Acquired with a Topcon TRC-NW400: 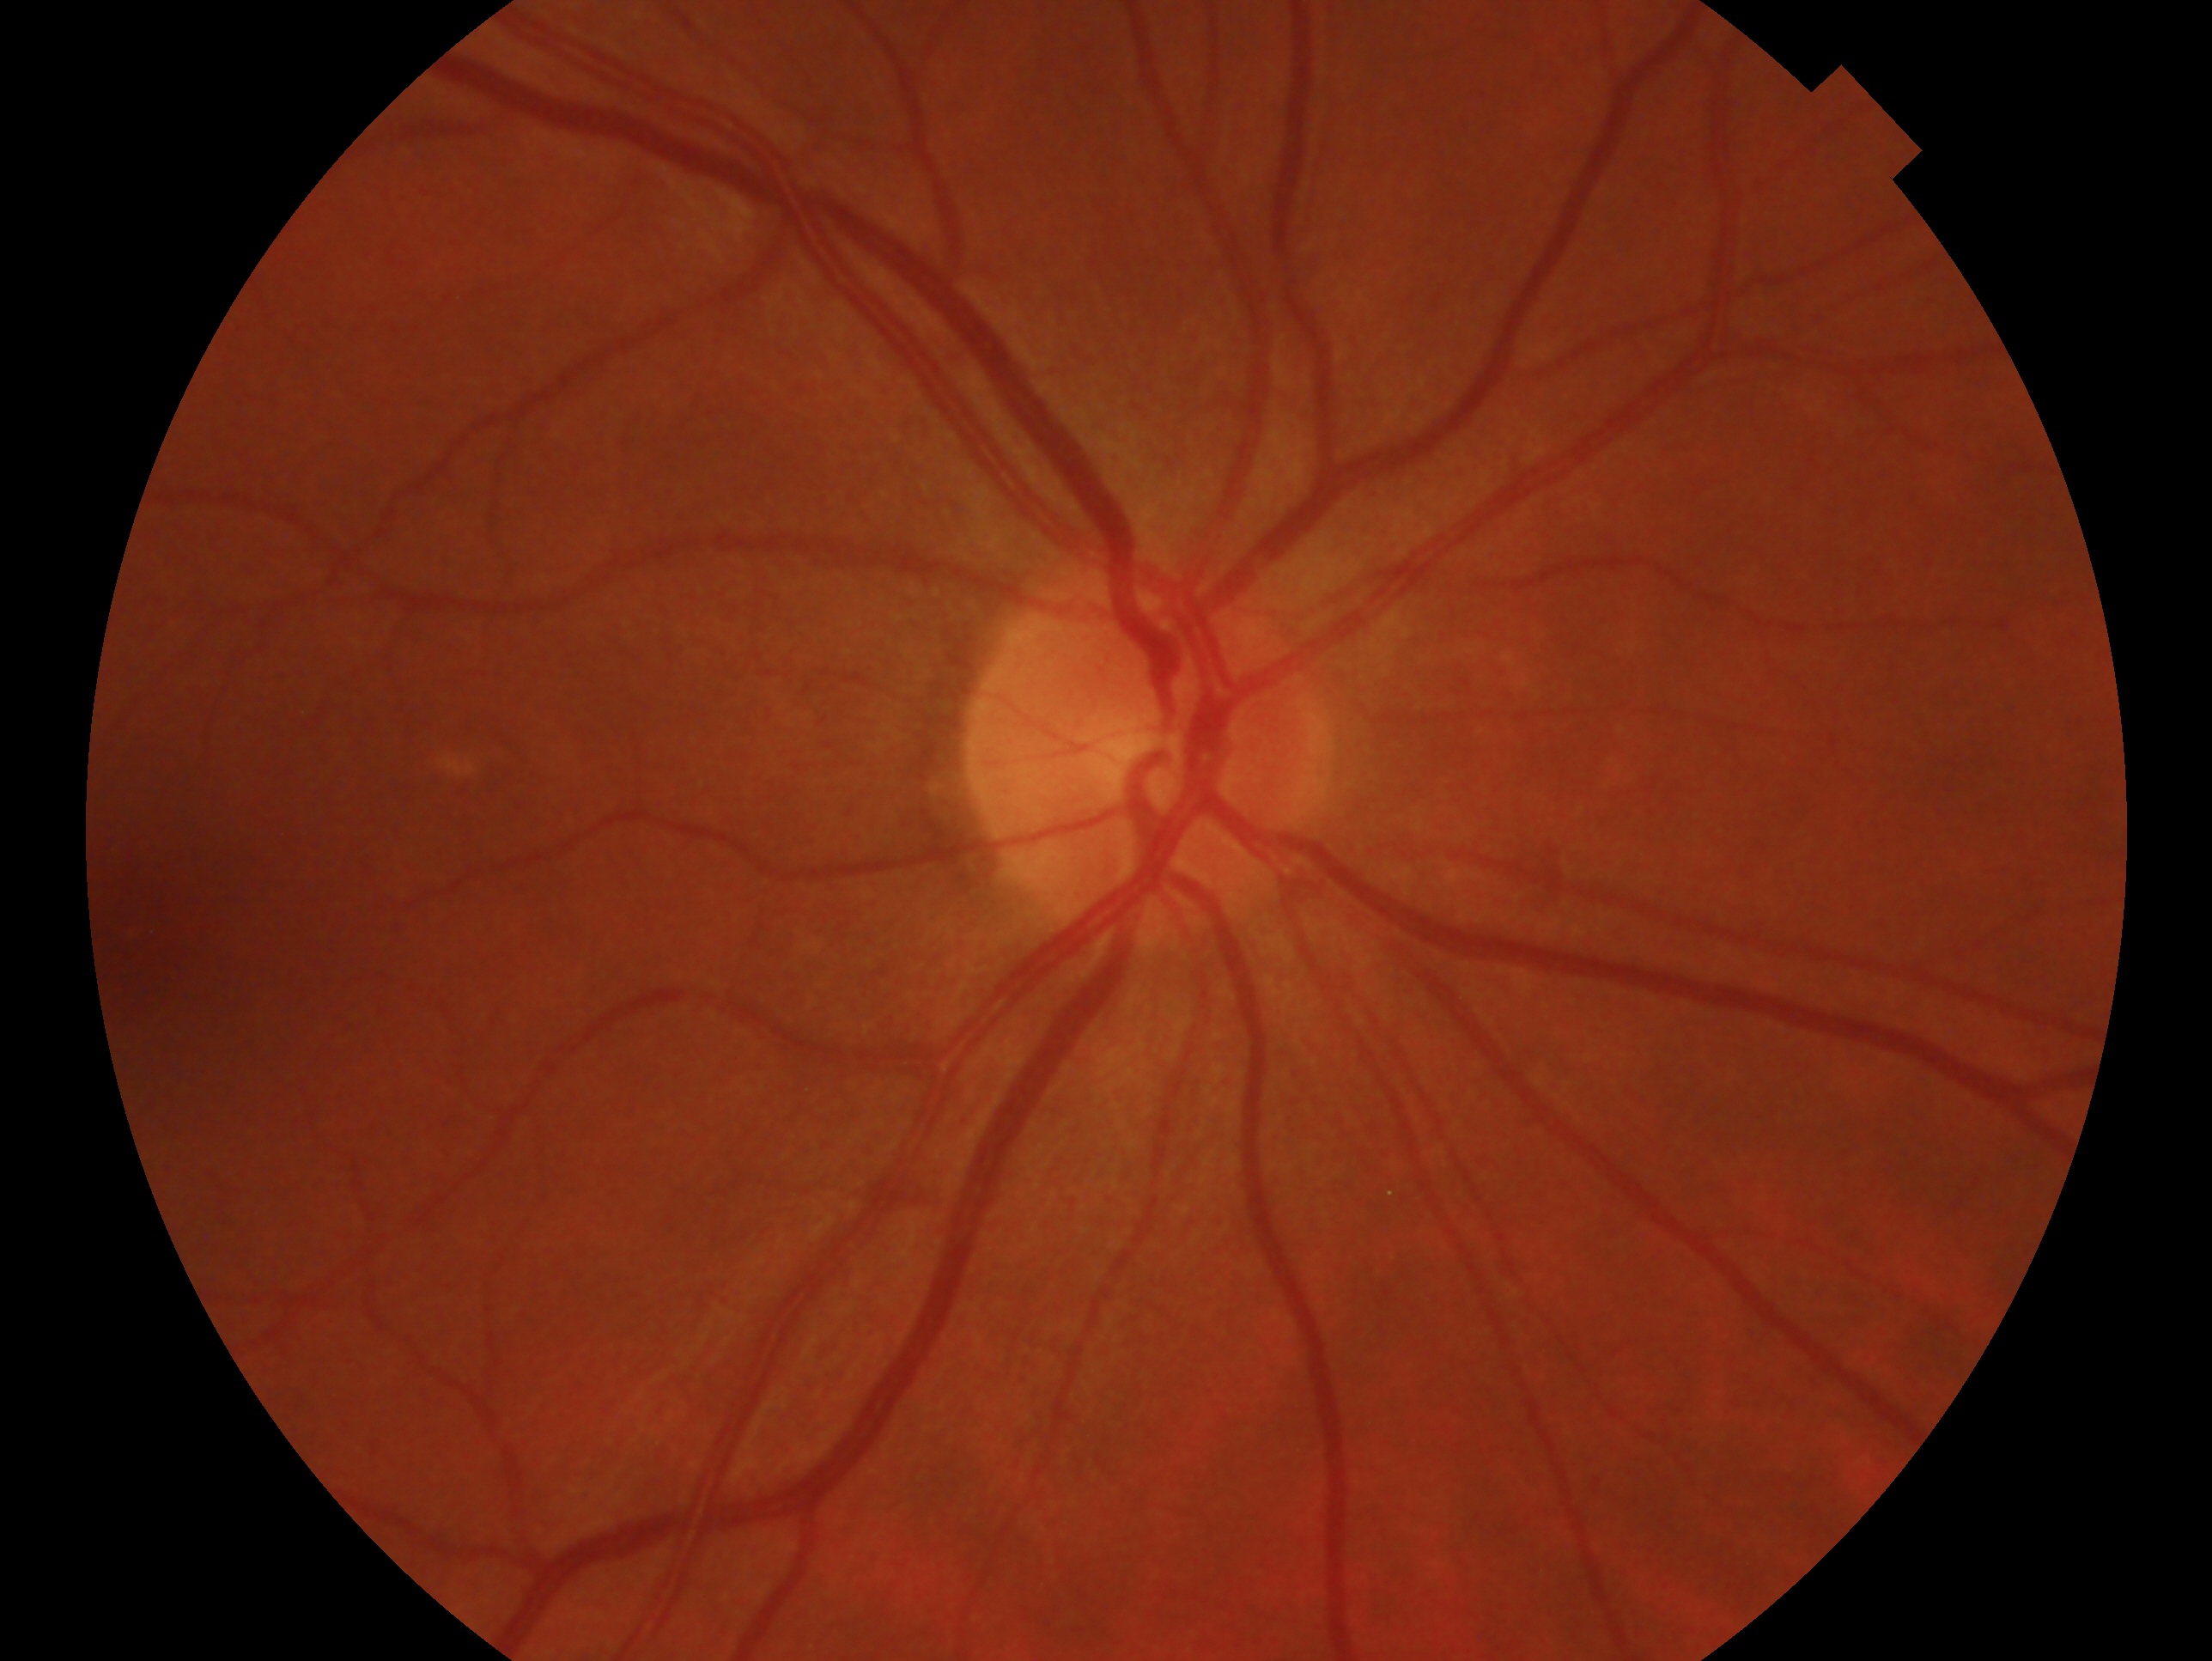

Glaucoma diagnosis: no glaucoma.
This is the right eye.